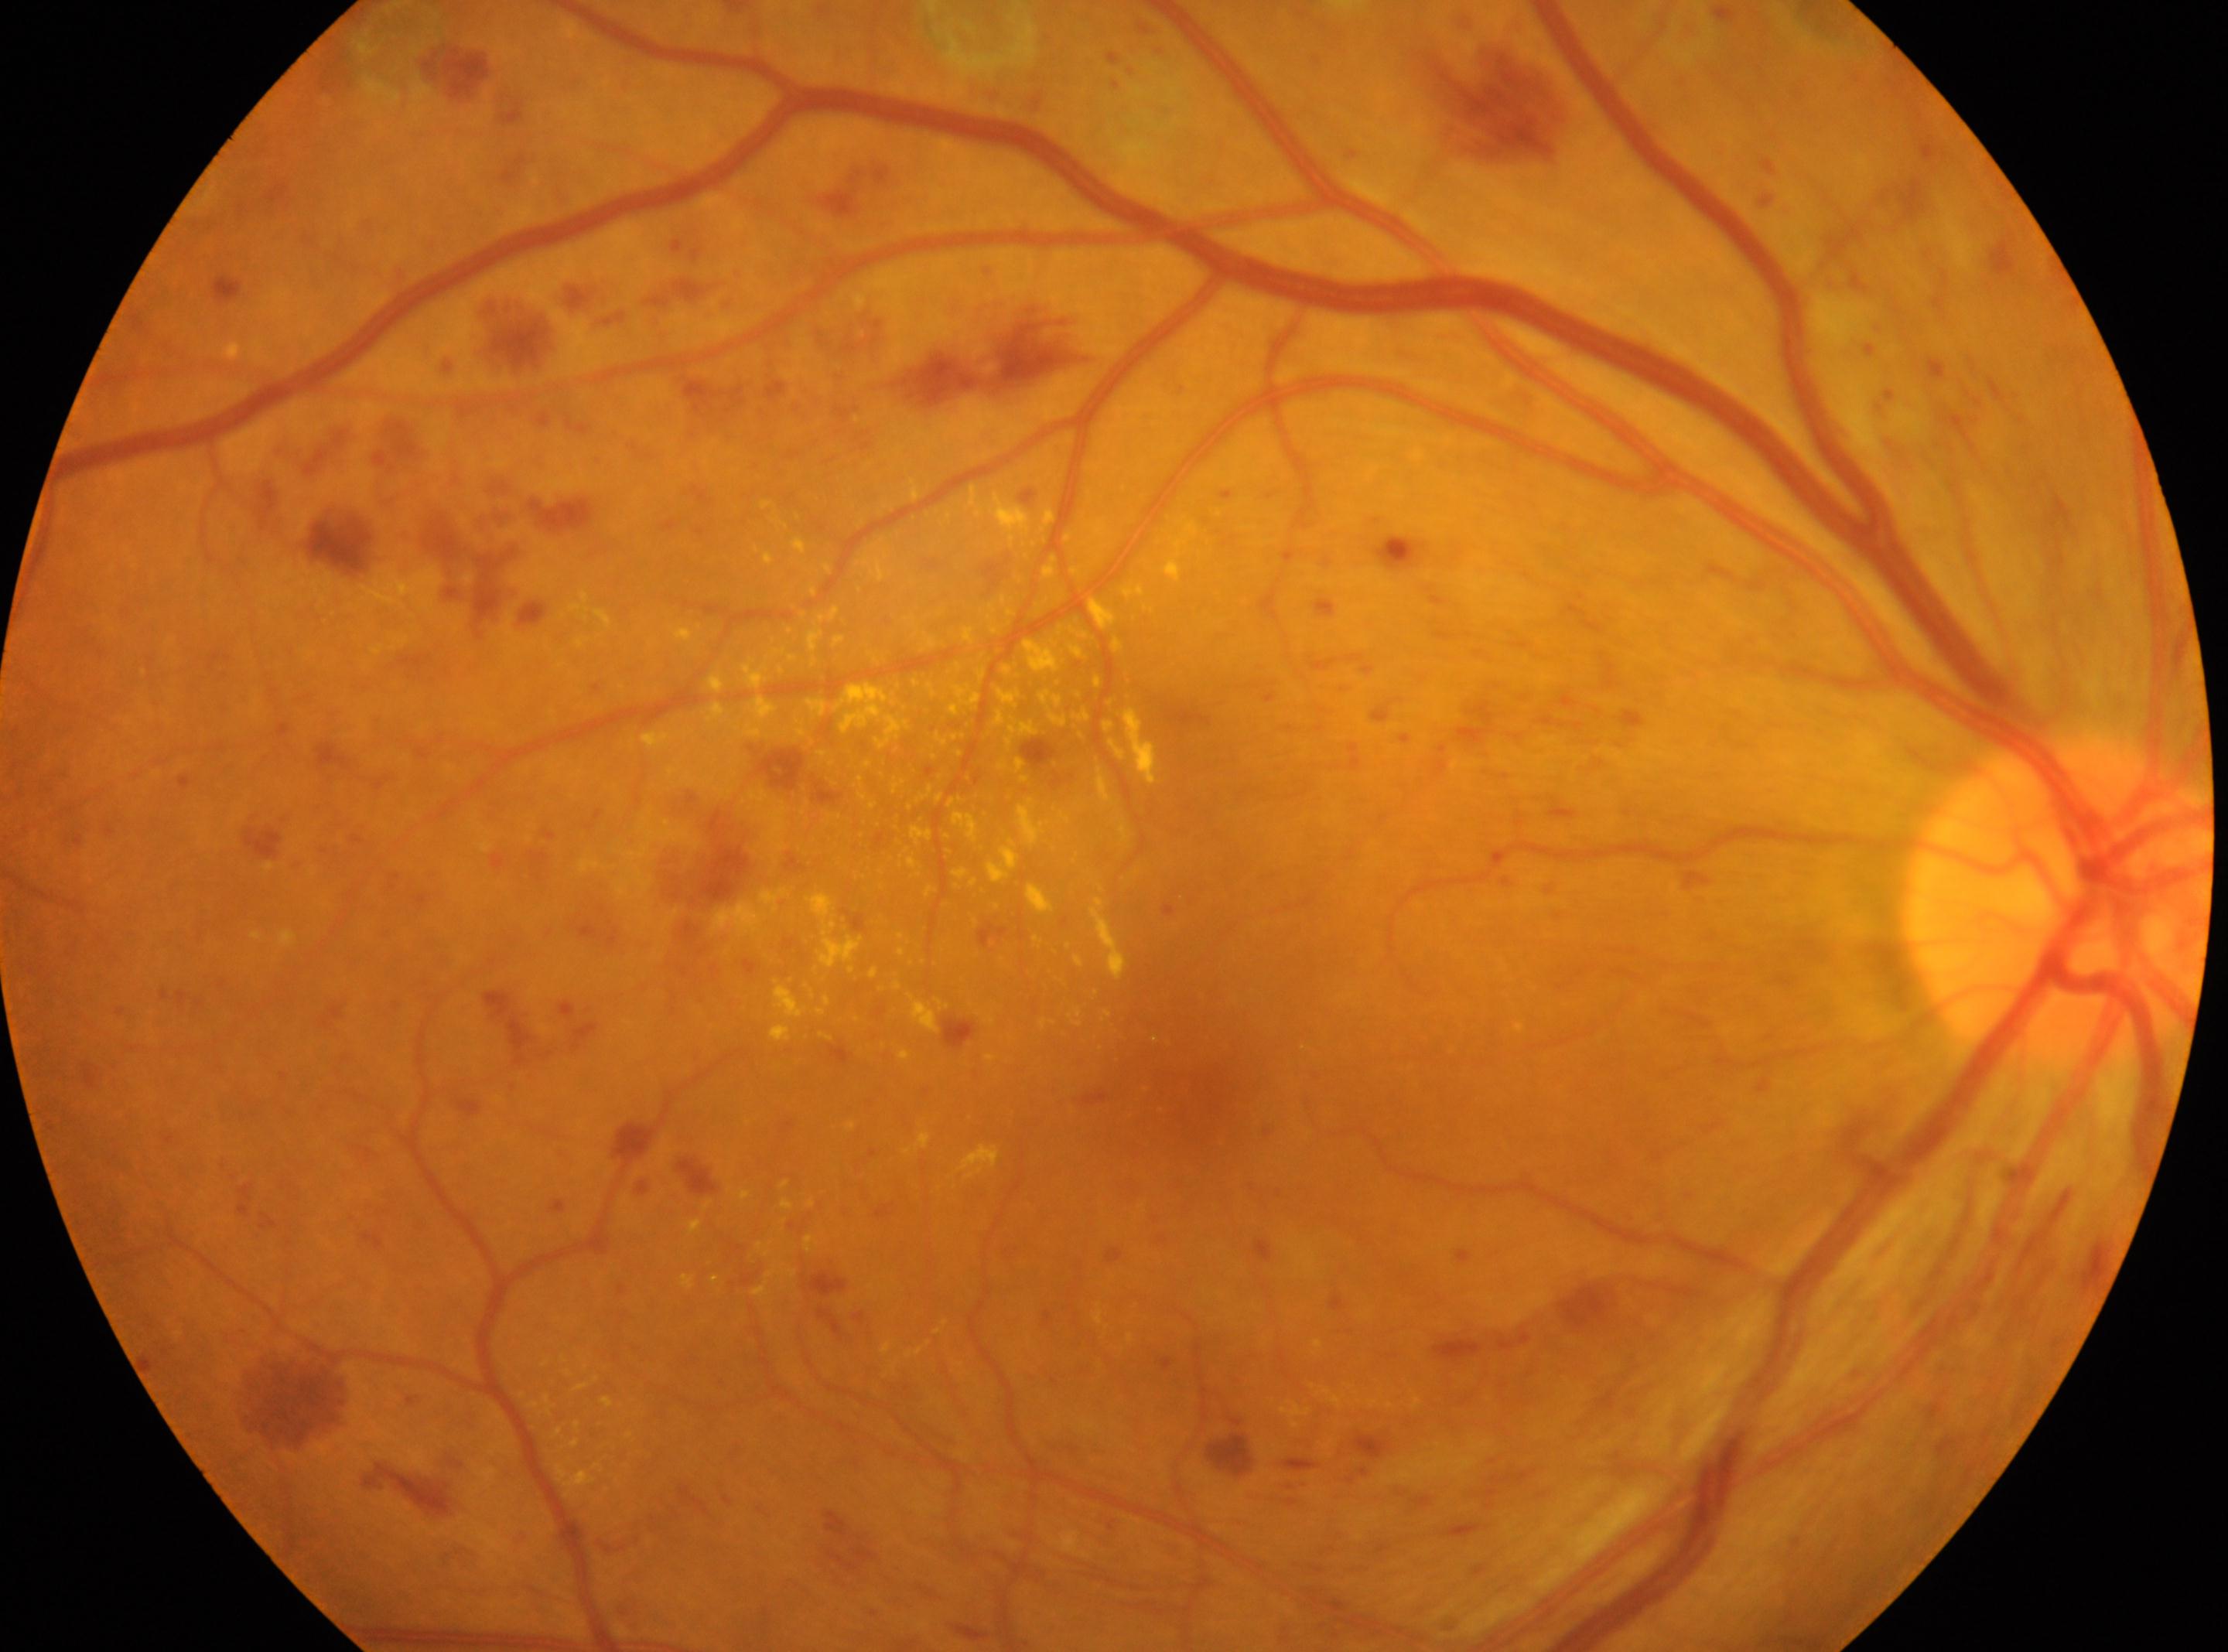 This is the right eye. Optic disc center located at 2058px, 903px. Diabetic retinopathy severity is DR with laser photocoagulation scars. Fovea centralis: 1188px, 1069px.